Camera: Clarity RetCam 3 (130° FOV) · wide-field fundus photograph of an infant · 640x480px
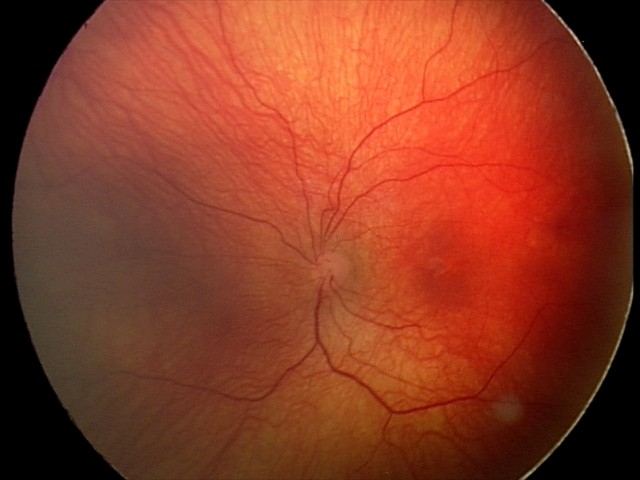
Assessment: status post ROP | plus disease: absent.